45° field of view.
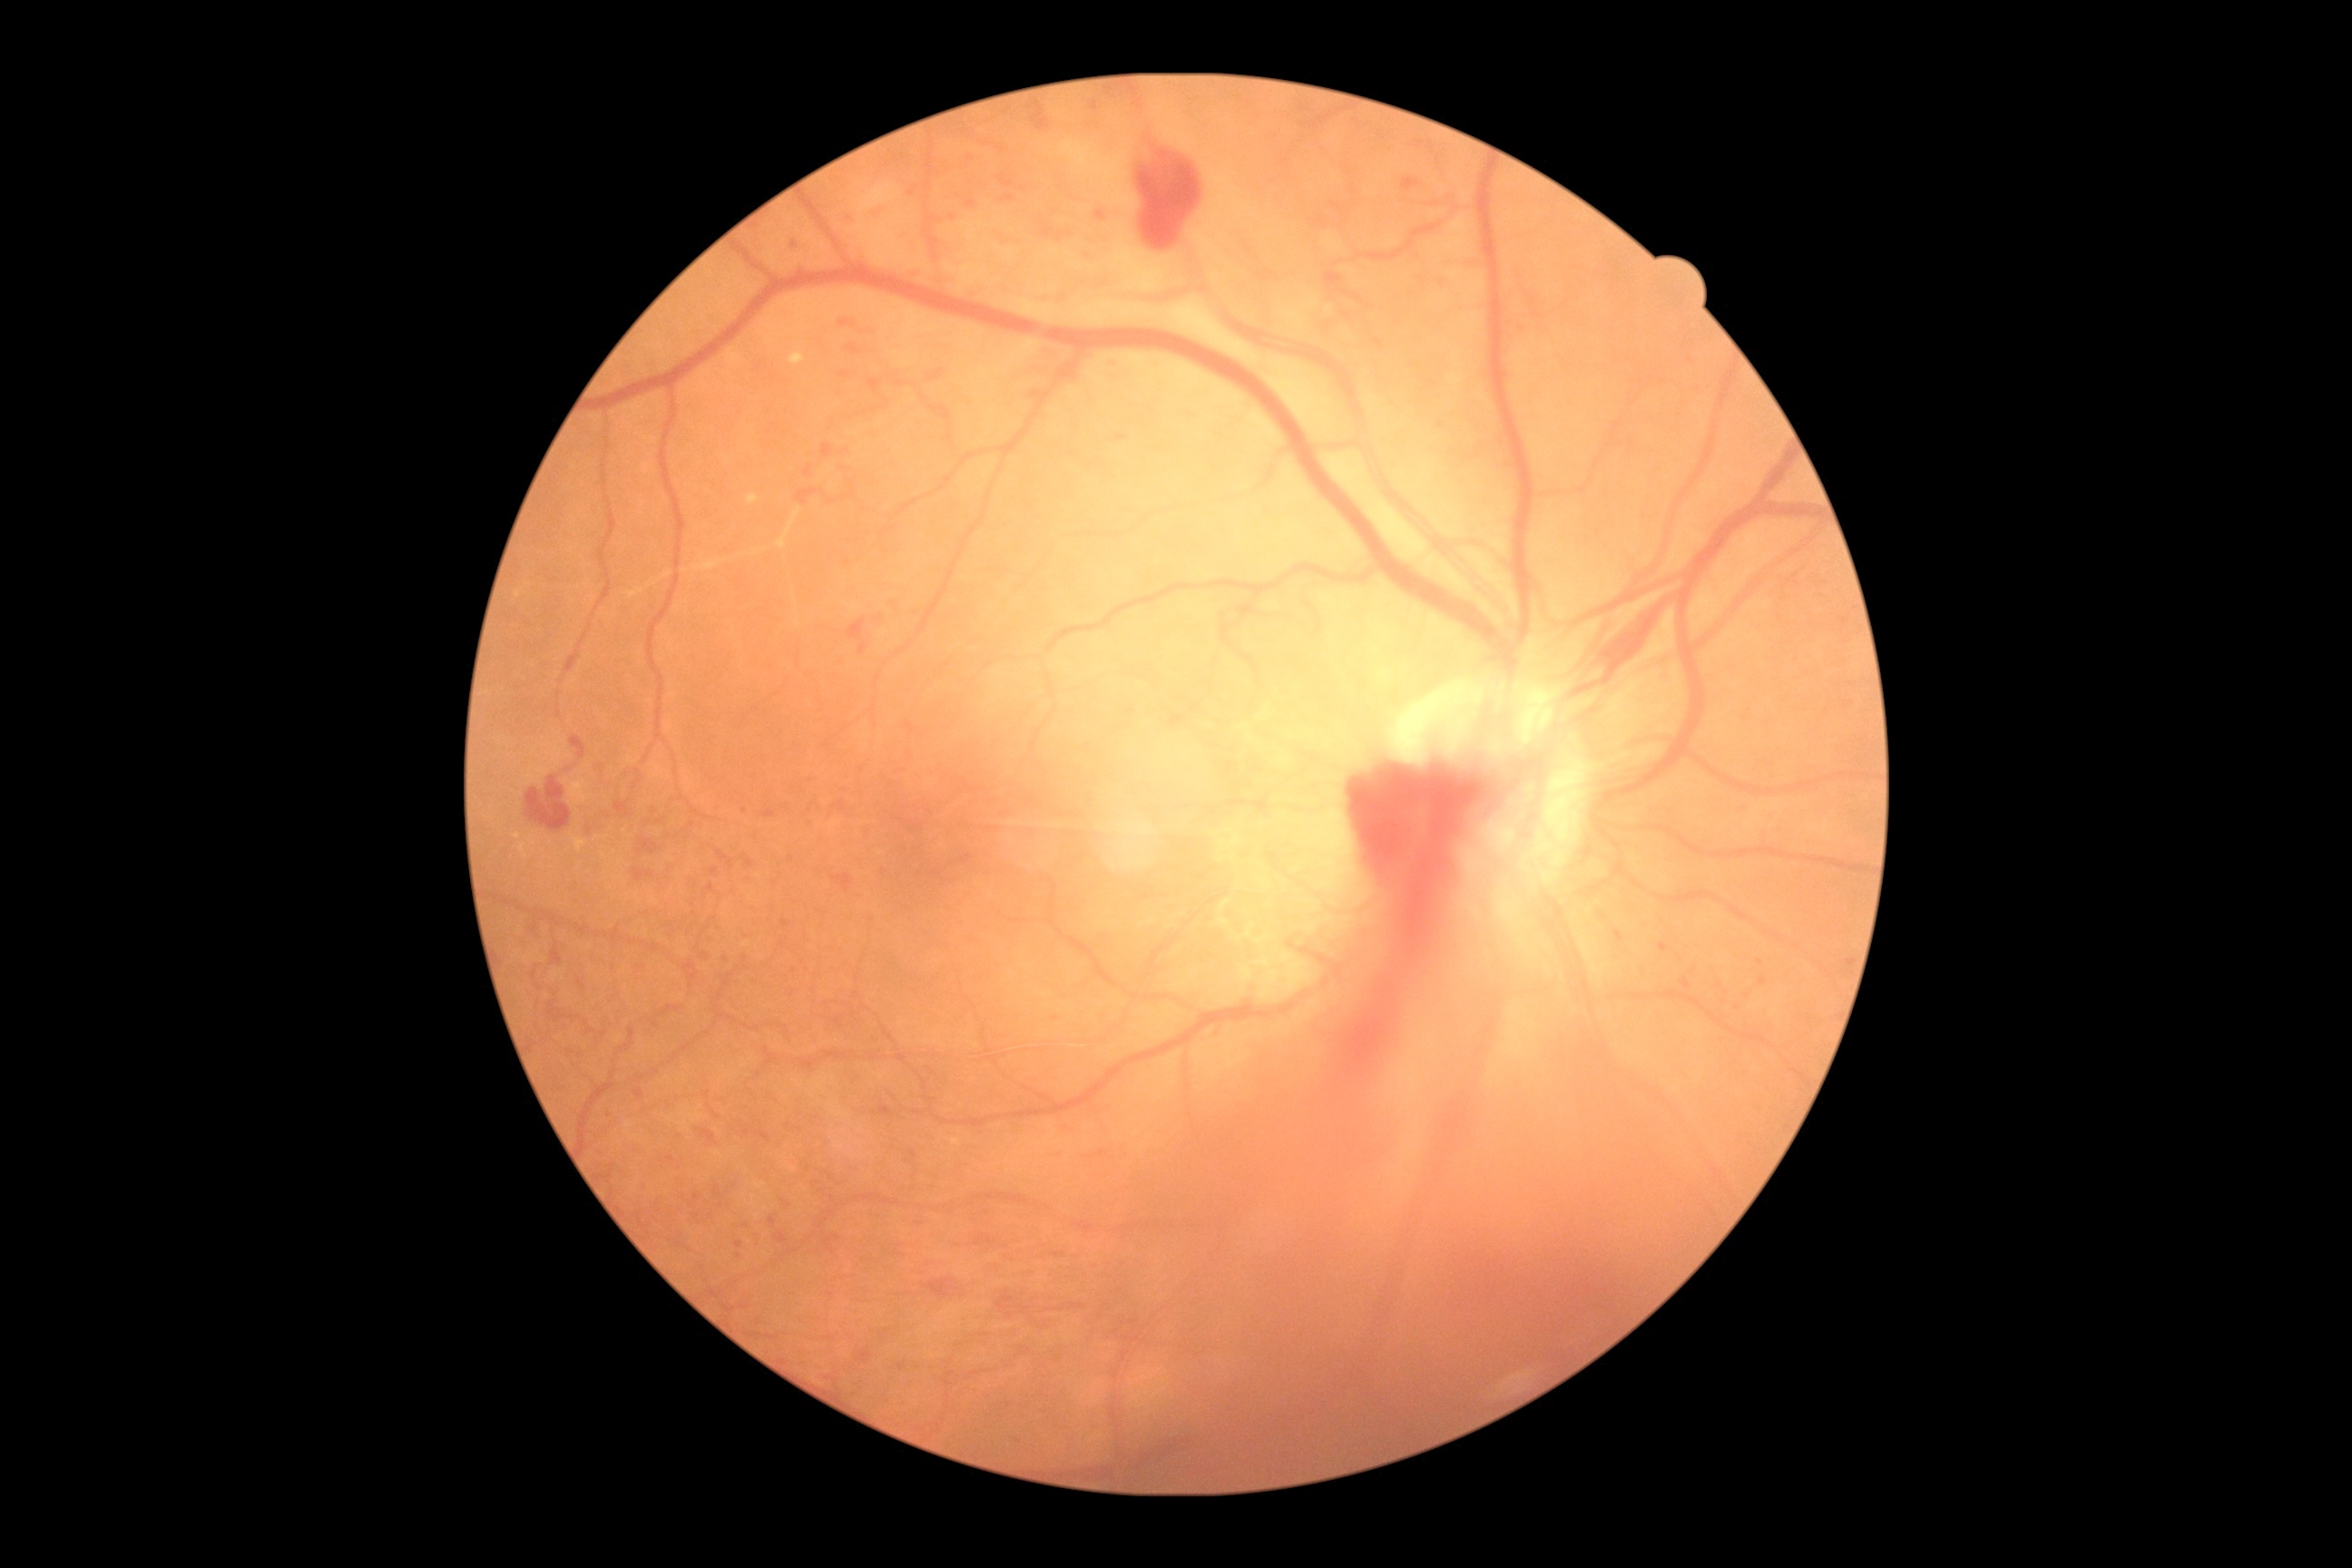 DR class=proliferative diabetic retinopathy; DR grade=PDR (4).